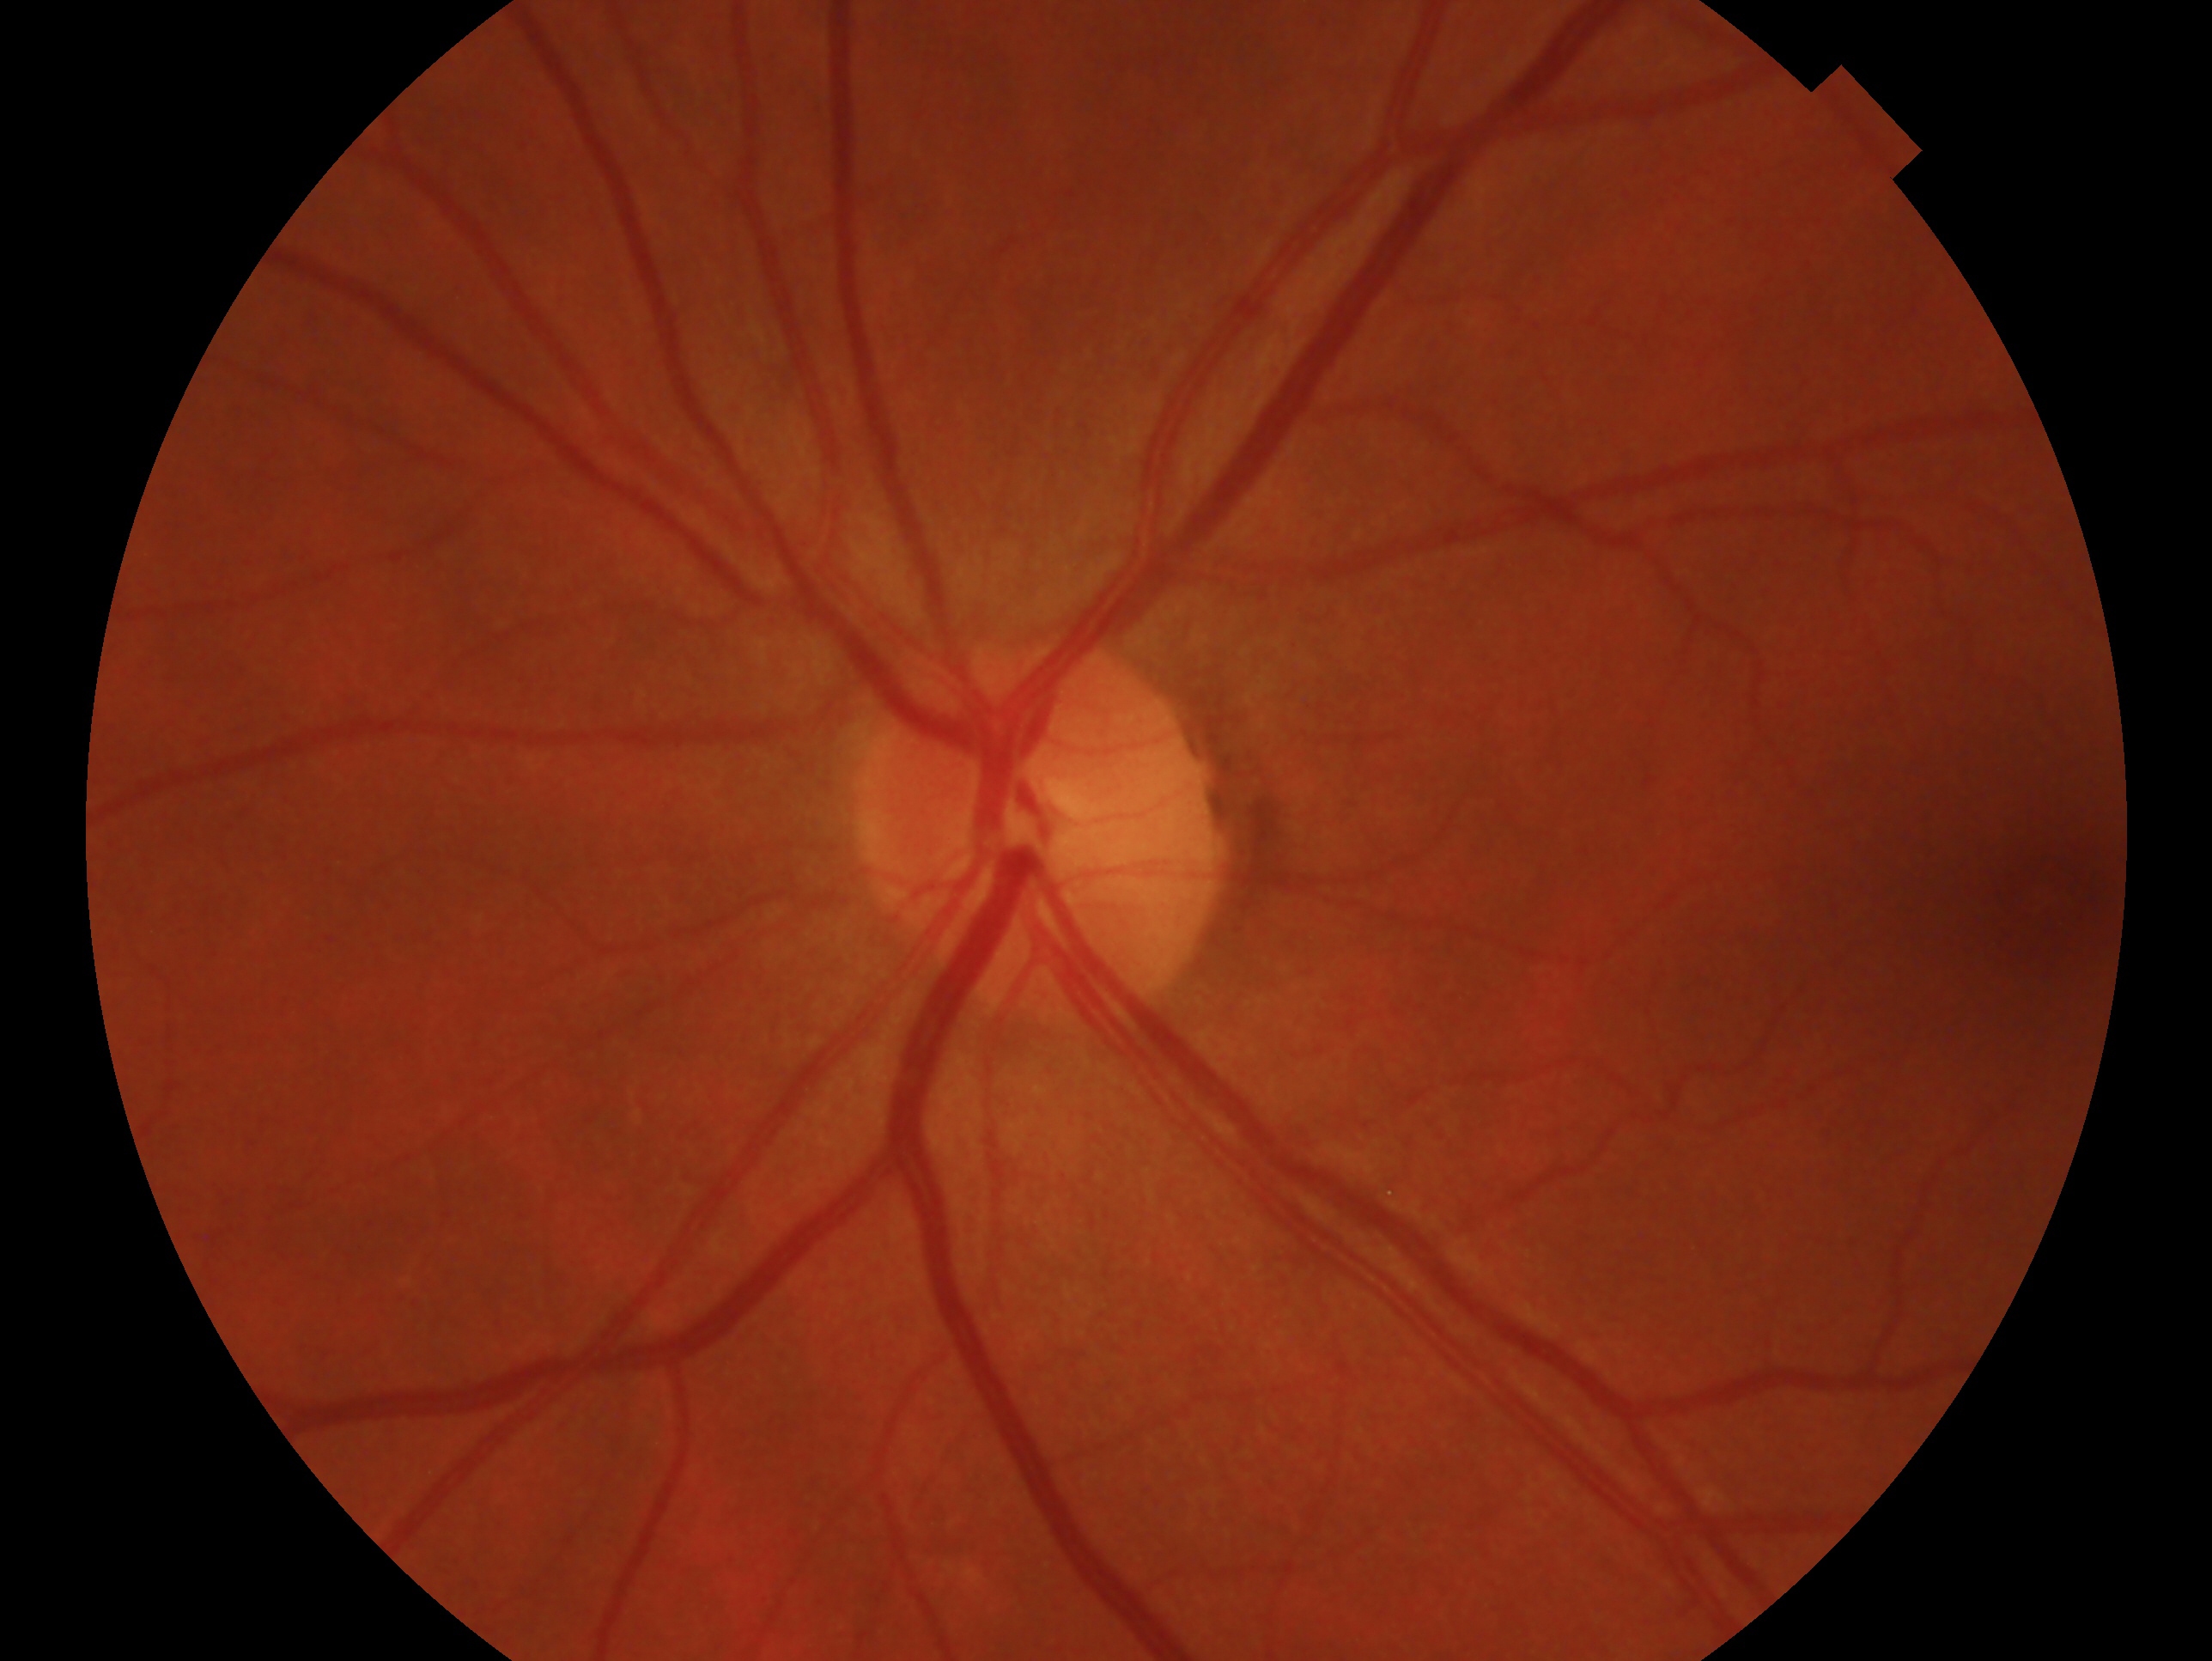 Eye: left eye.
Glaucoma assessment — no glaucoma.